1932x1910px. Fundus photo. 45° FOV.
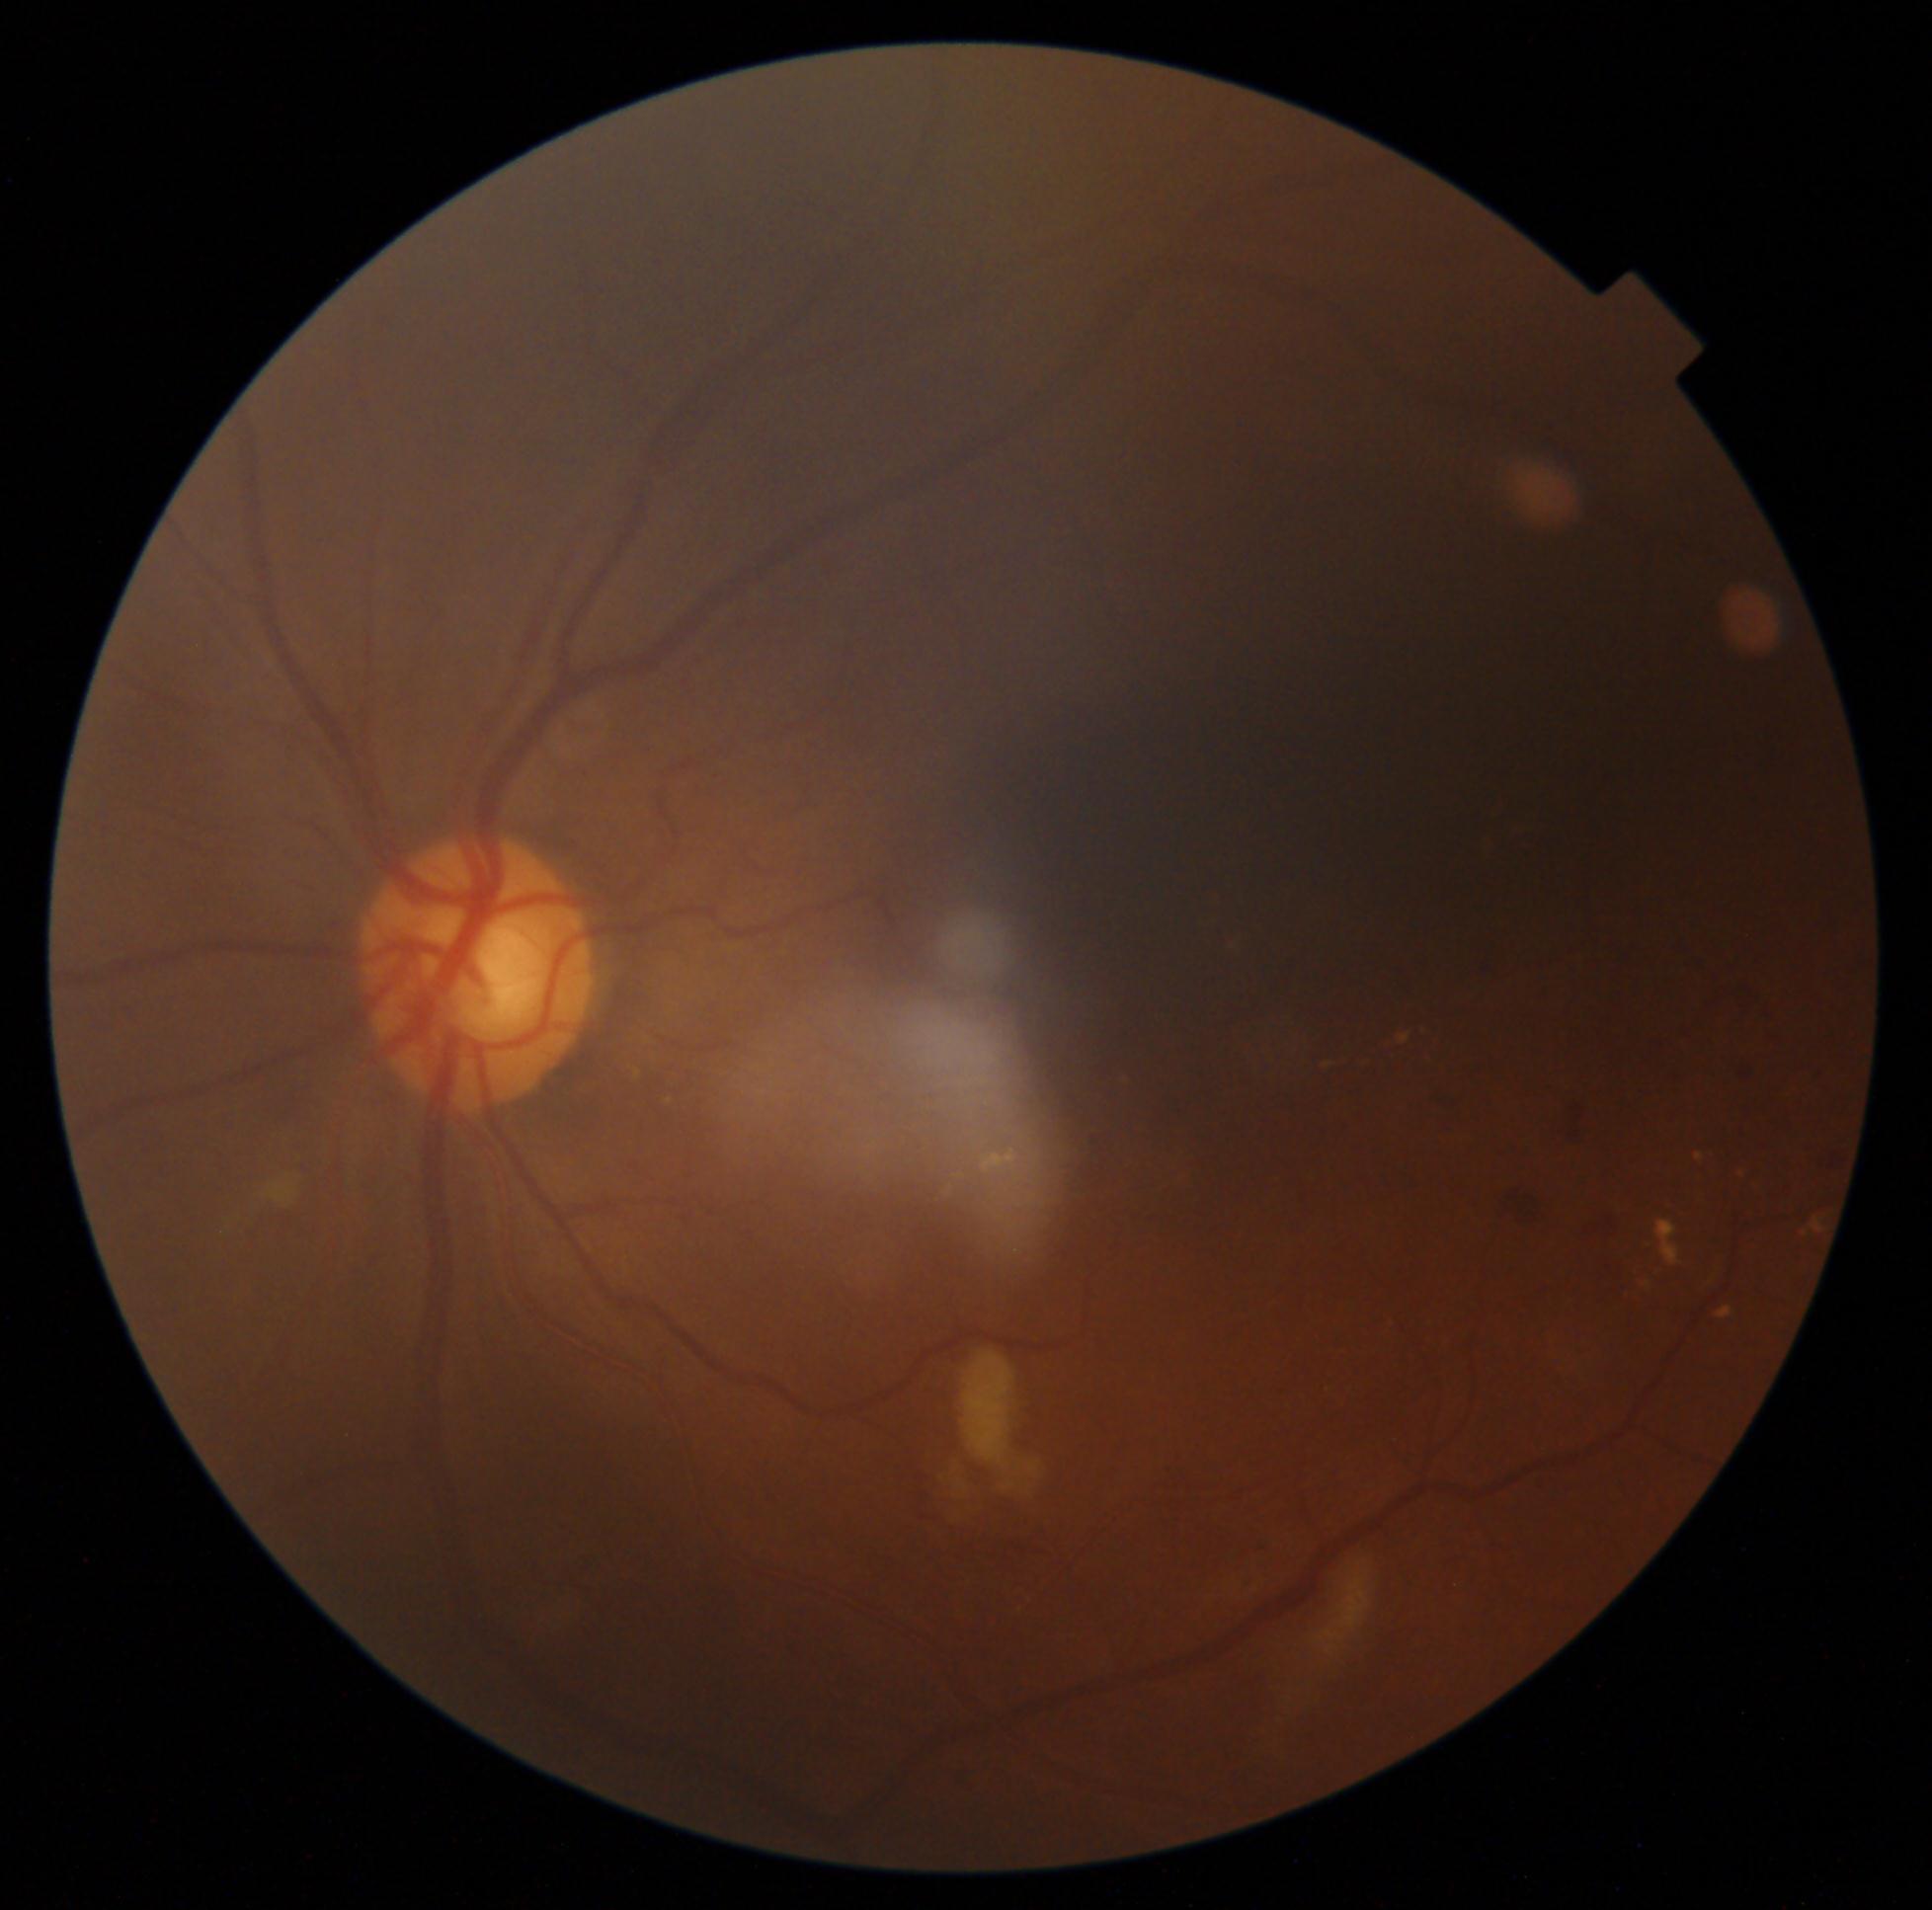
DR severity is grade 2 (moderate NPDR).